Fundus photo · 45° field of view: 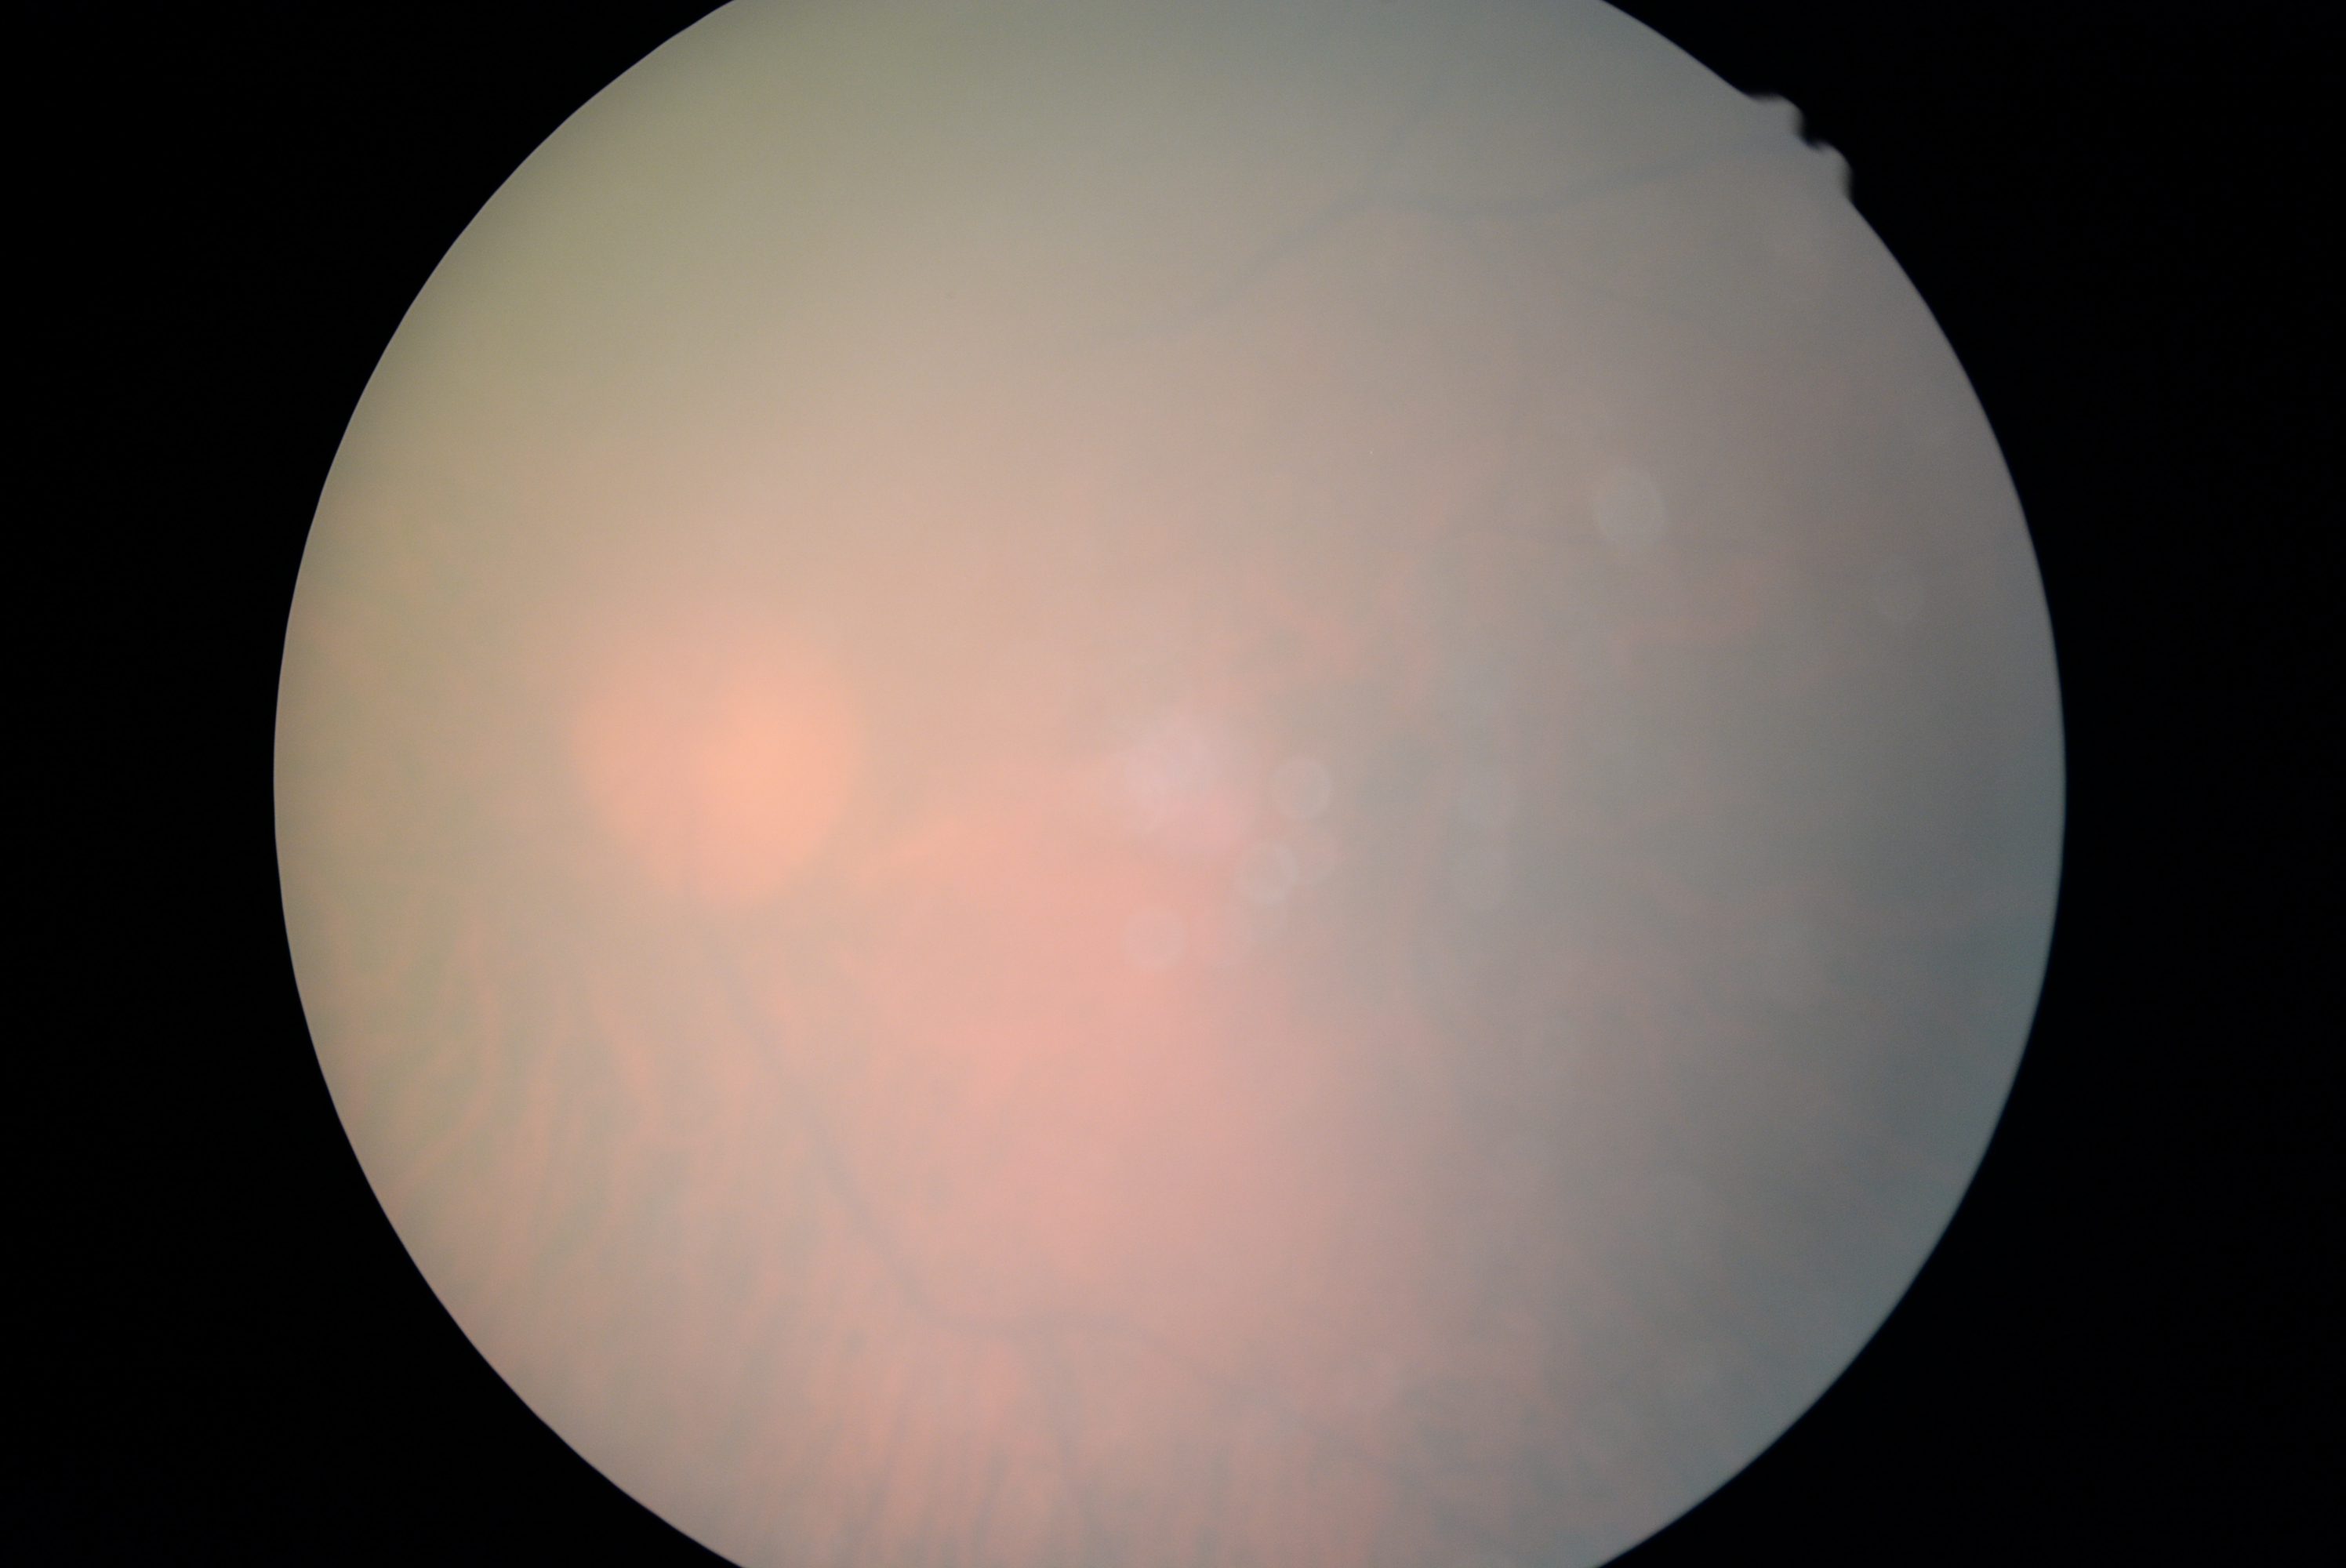

Image quality is insufficient for diabetic retinopathy assessment.
DR is ungradable due to poor image quality.